Color fundus photograph
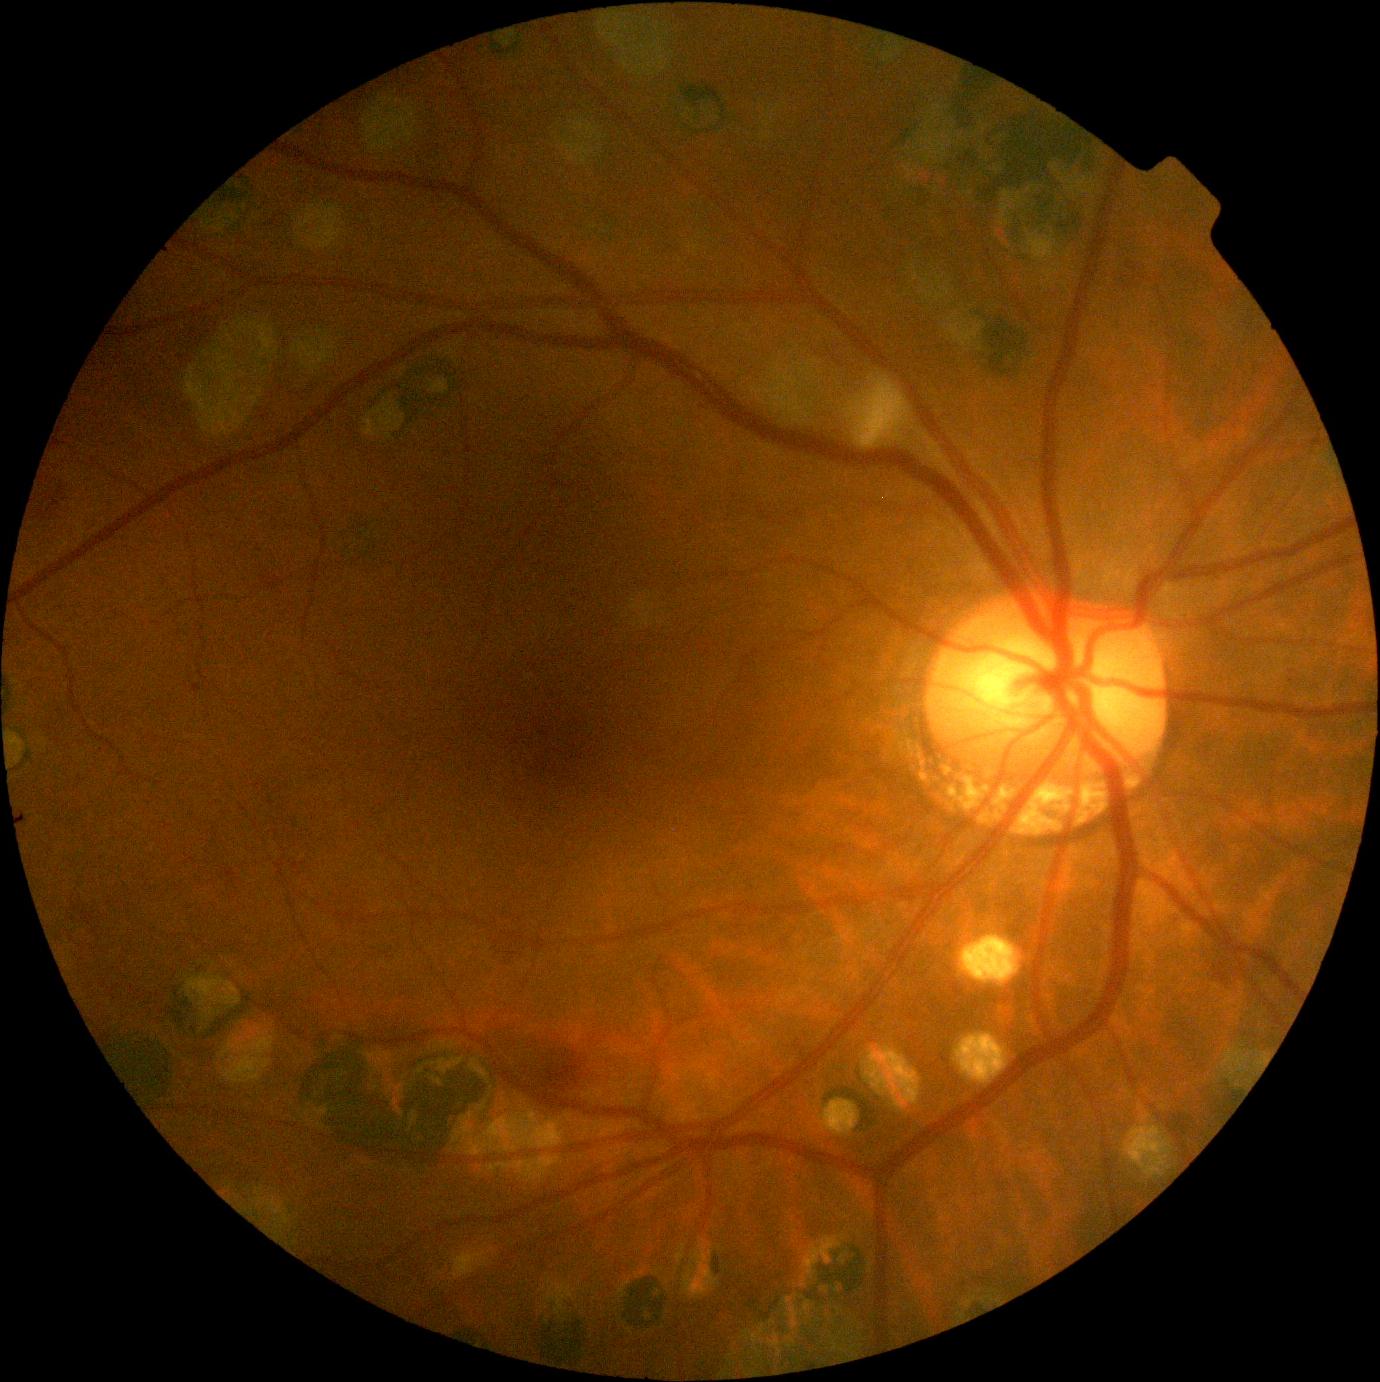

Diabetic retinopathy grade: moderate NPDR (2).